Color fundus photograph — 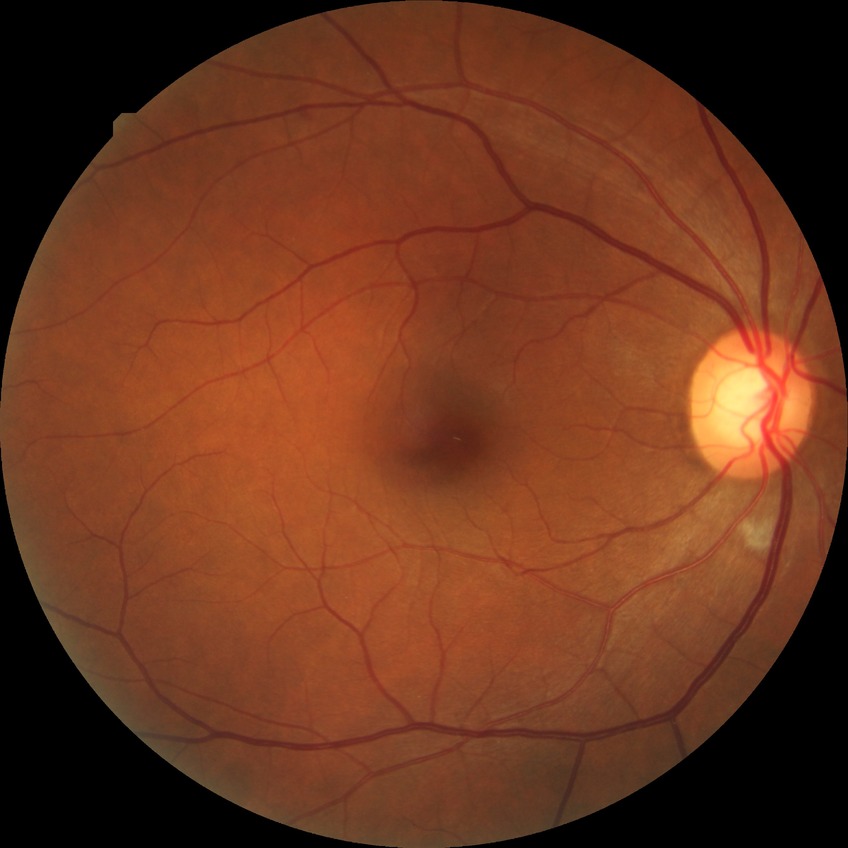

Diabetic retinopathy stage is no diabetic retinopathy.